Image size 2212x1661; axial length (AL) 24.97 mm; undilated pupil; centered on the optic disc; 30-degree field of view; 50-year-old patient:
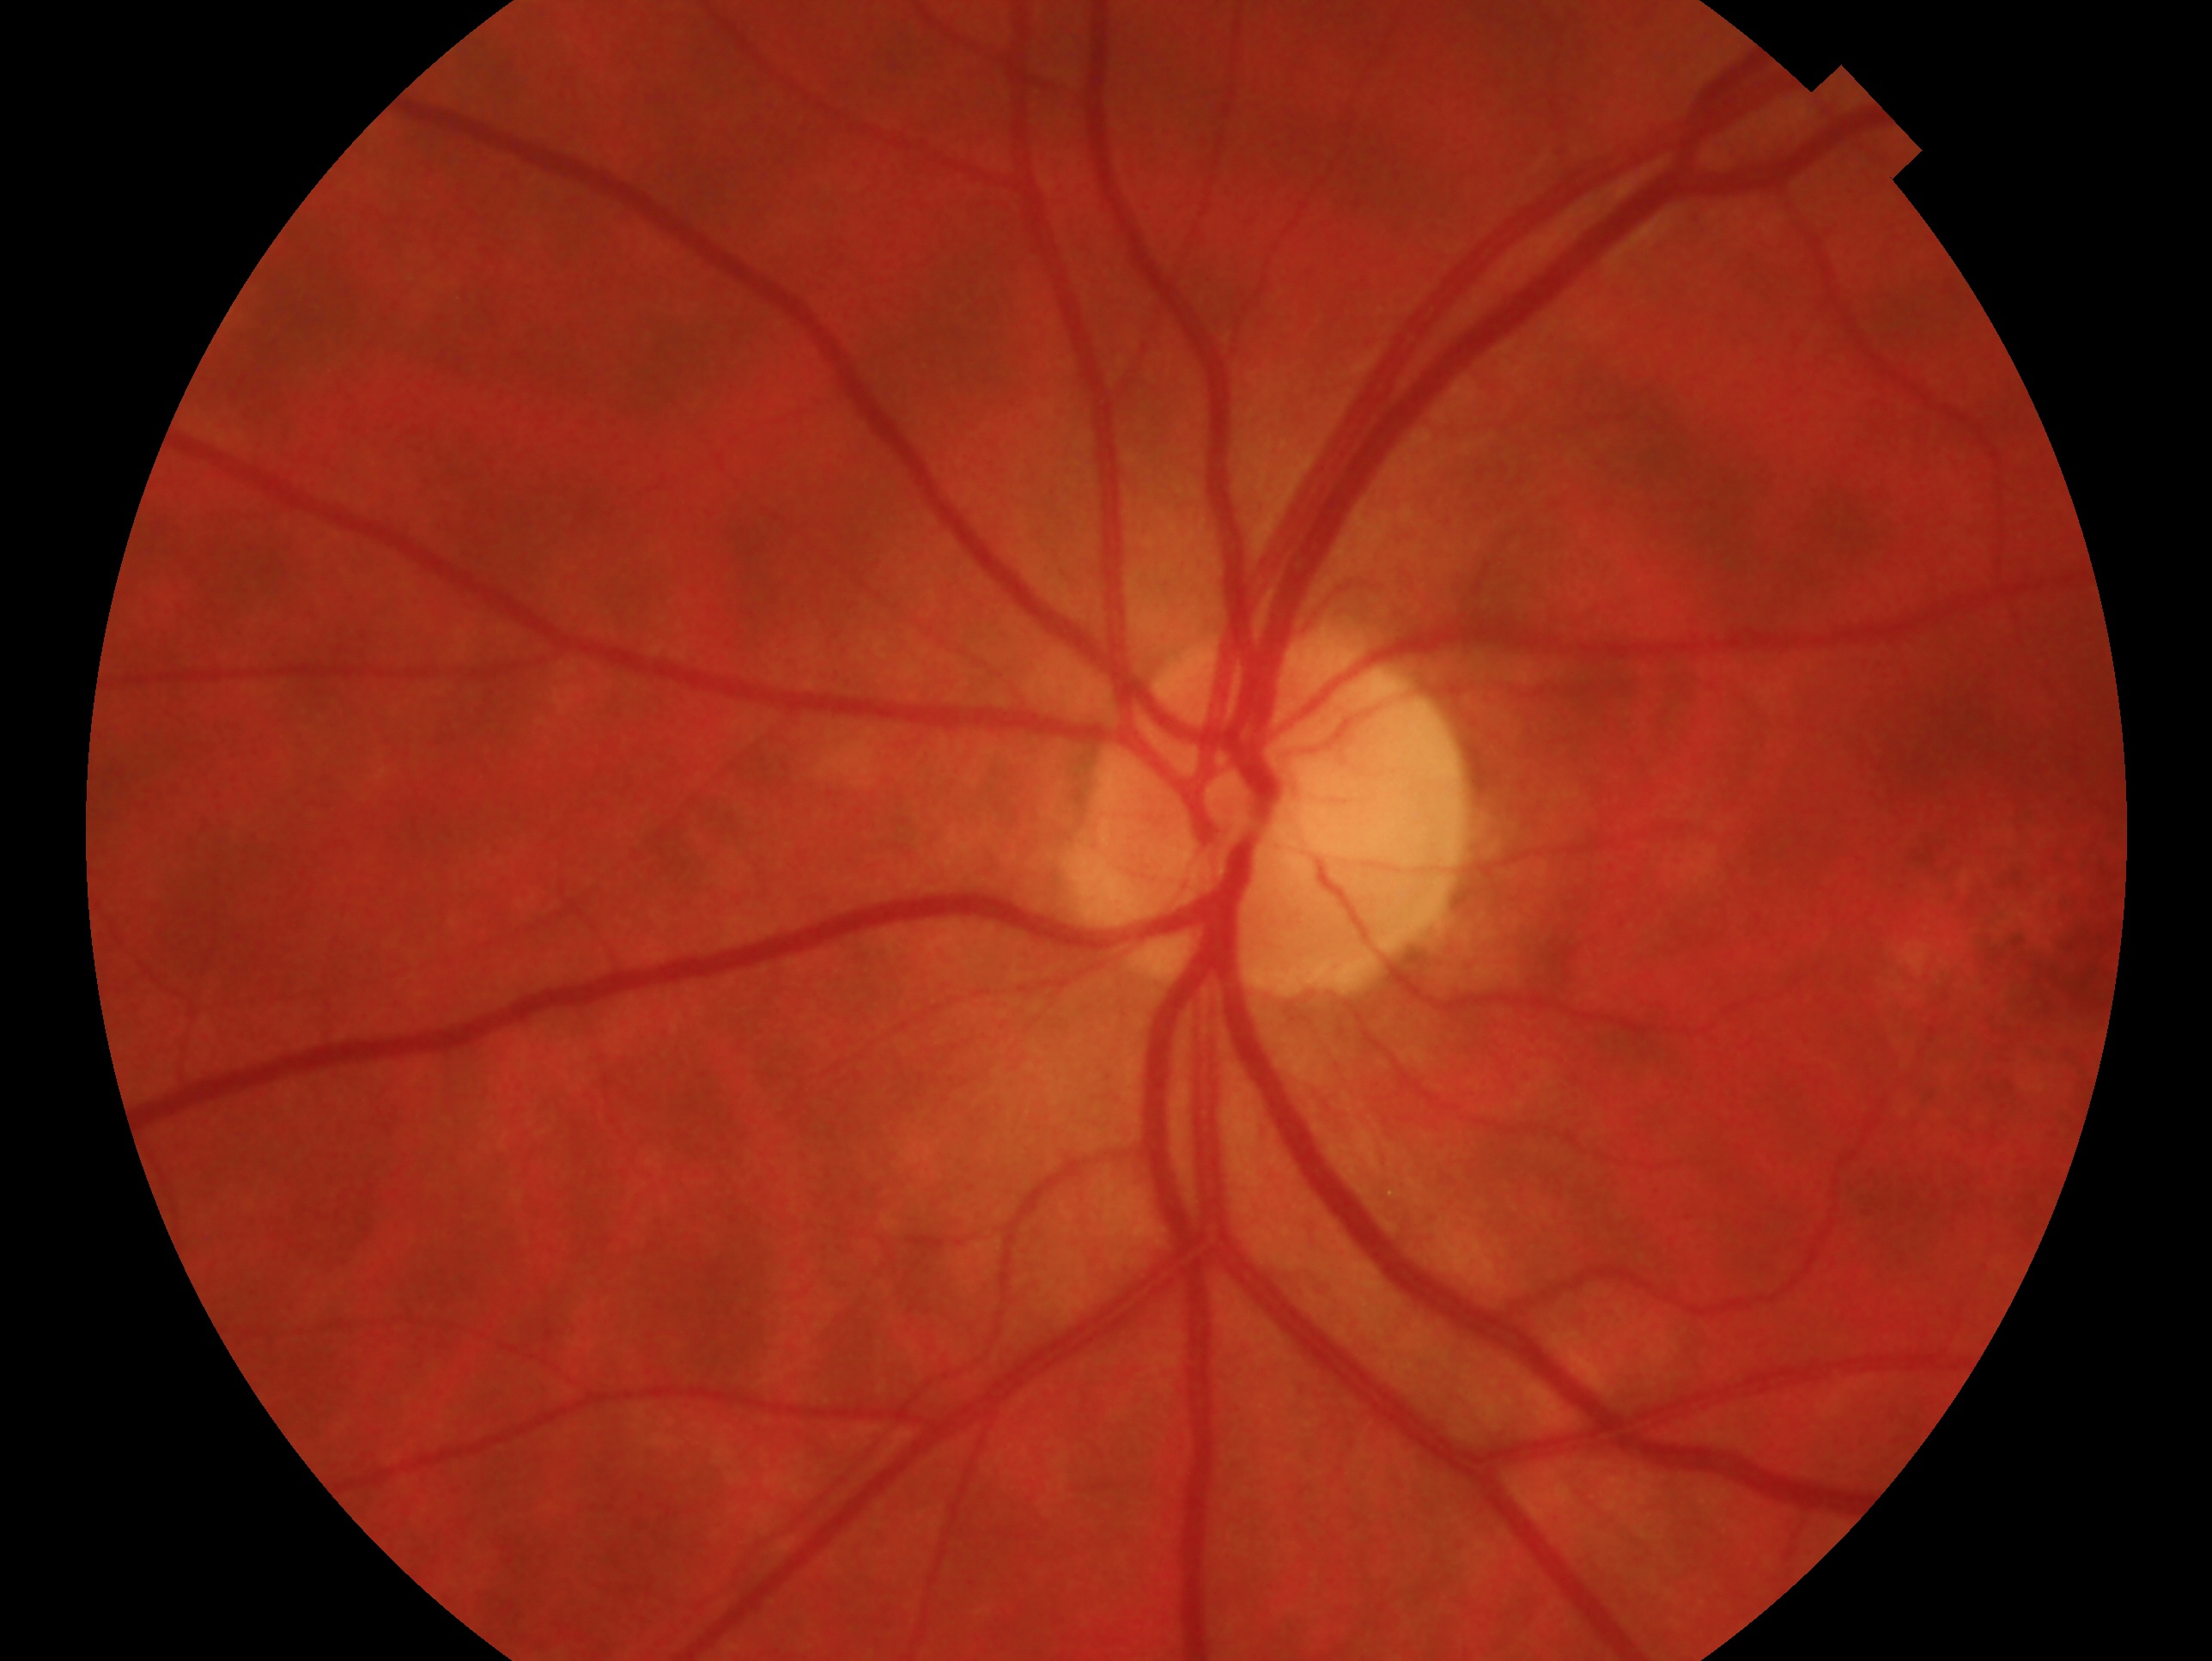

Impression: no glaucomatous findings. This is the left eye.